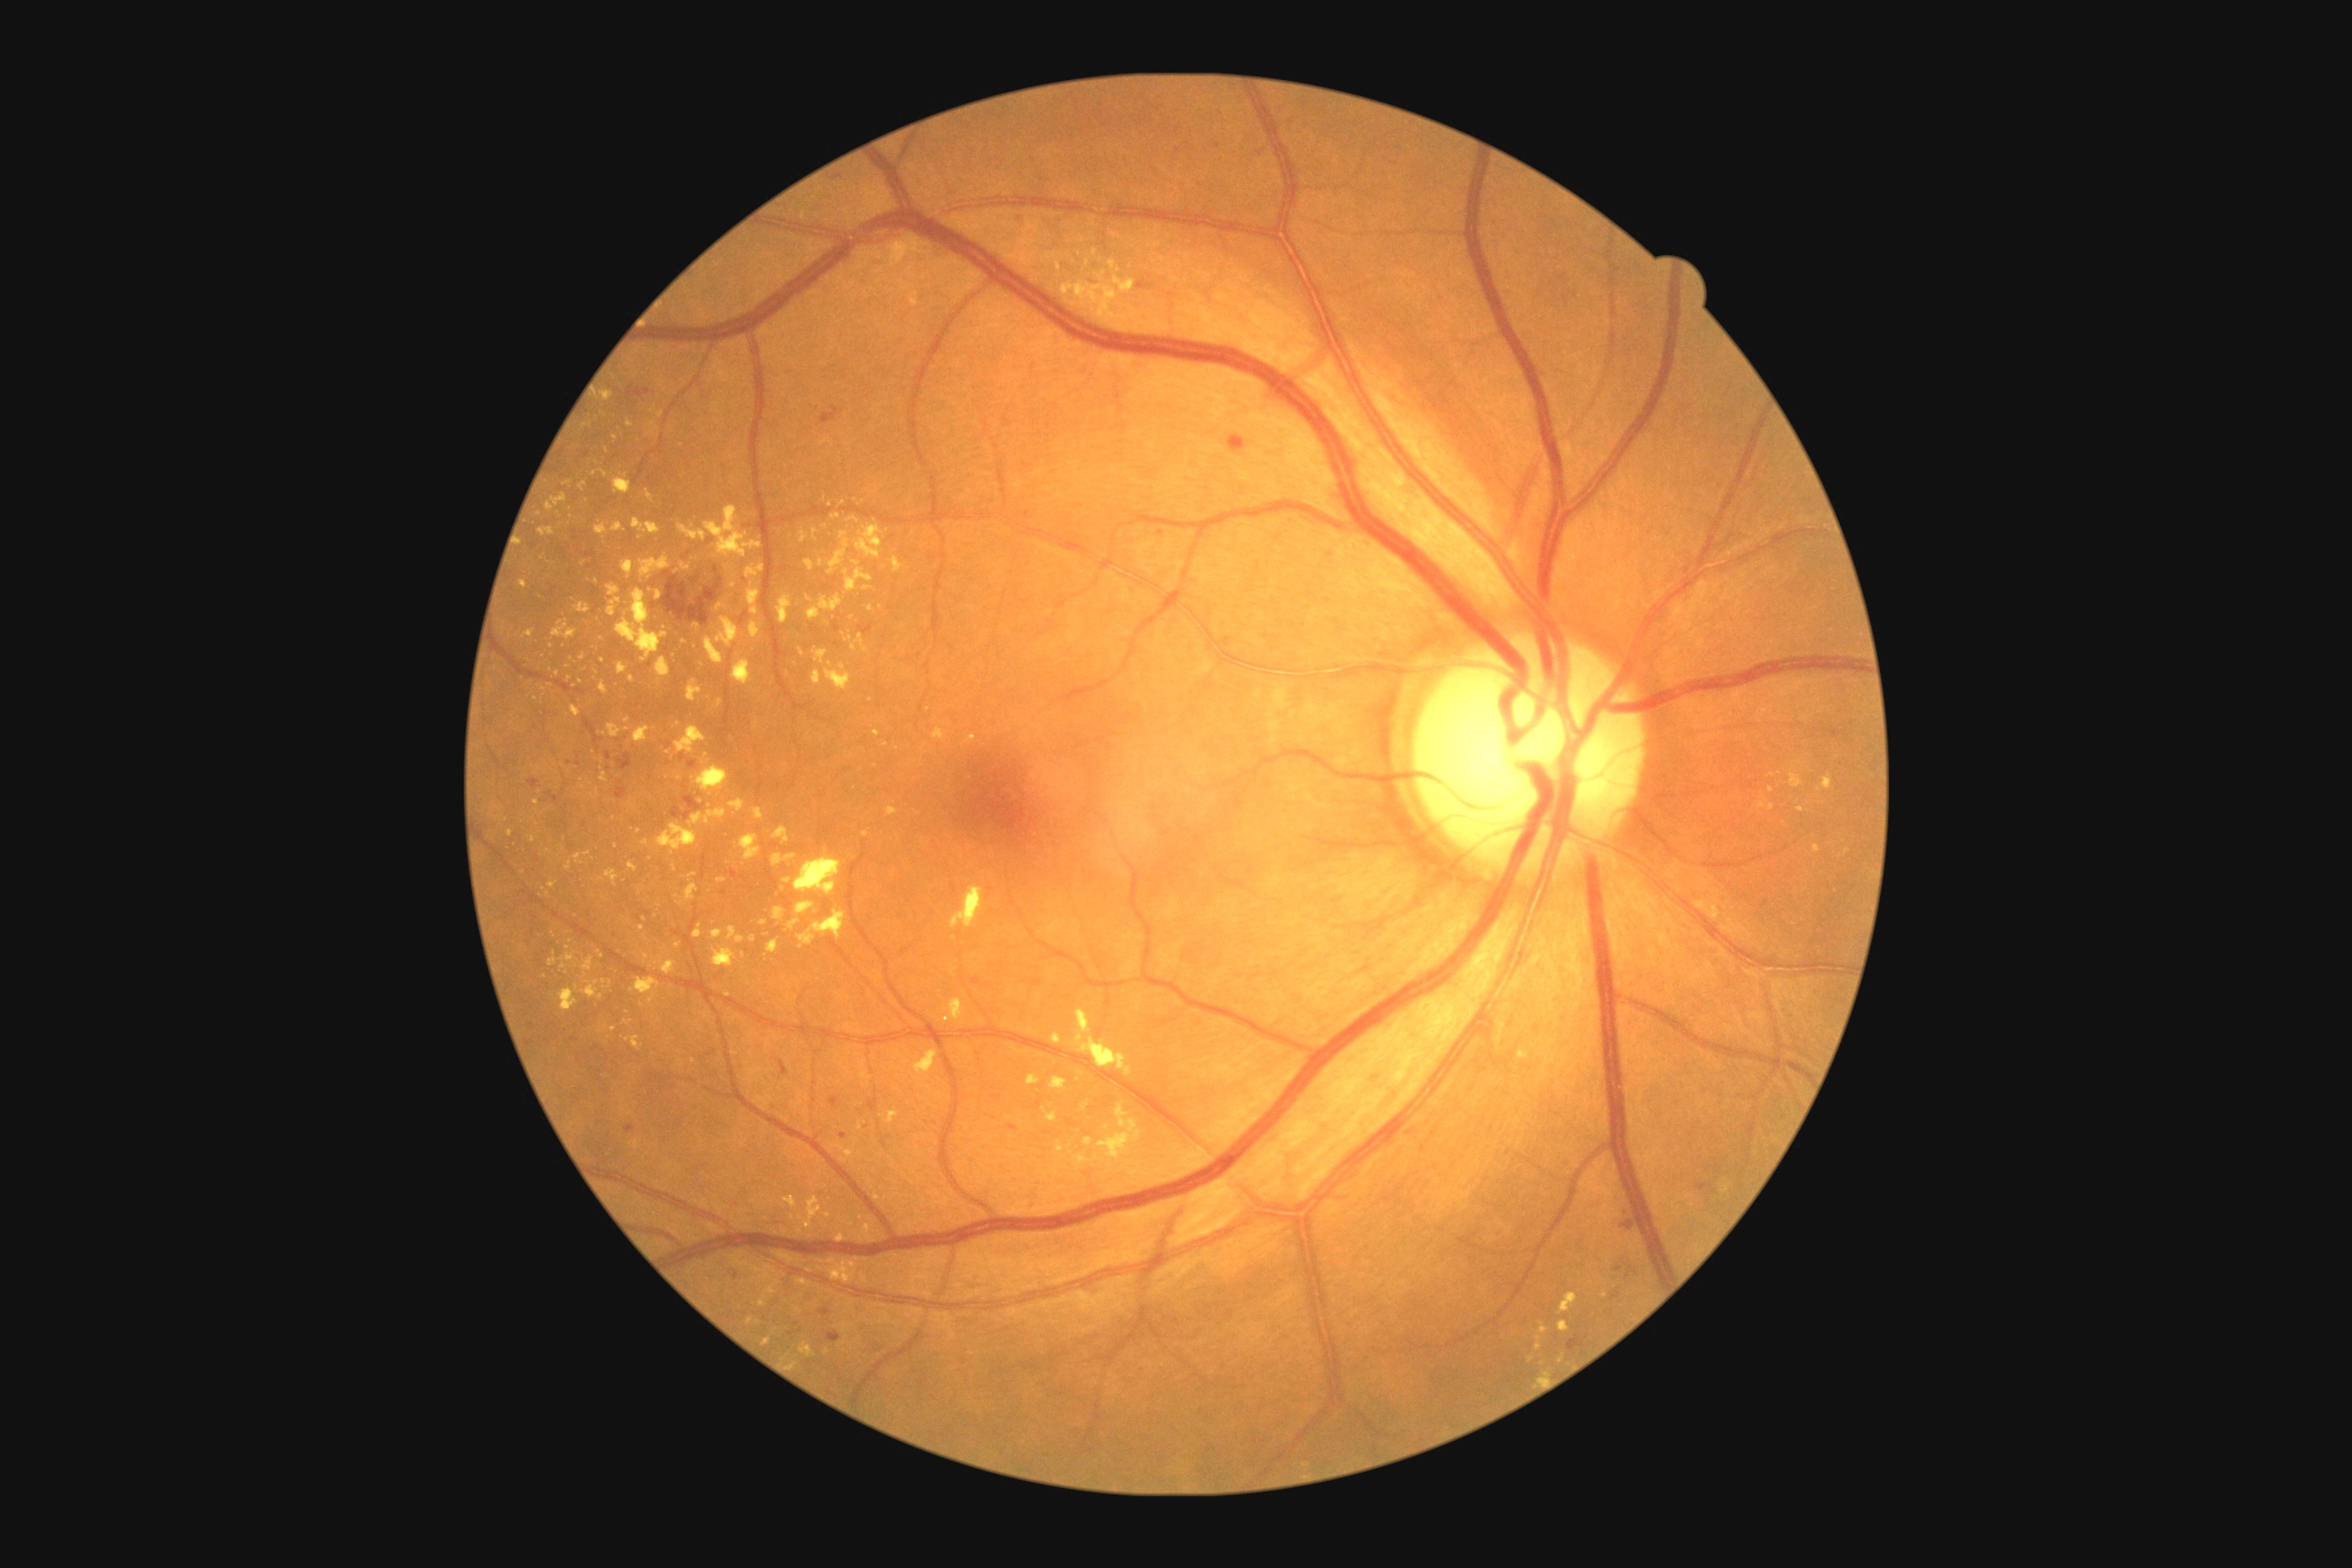

partial: true
dr_grade: 2
lesions:
  ex:
    - 618, 663, 627, 674
    - 838, 1146, 854, 1157
    - 712, 948, 736, 968
    - 863, 830, 870, 838
    - 814, 649, 828, 665
    - 701, 754, 709, 765
    - 600, 723, 622, 738
    - 965, 734, 977, 745
    - 808, 596, 843, 622
    - 830, 514, 841, 520
  ex_small:
    - <pt>610,983</pt>
    - <pt>603,1031</pt>
    - <pt>845,1344</pt>
    - <pt>567,485</pt>
    - <pt>658,429</pt>
    - <pt>552,647</pt>
    - <pt>1094,253</pt>
    - <pt>680,778</pt>